Fundus photograph cropped around the optic nerve head; camera: Topcon TRC — 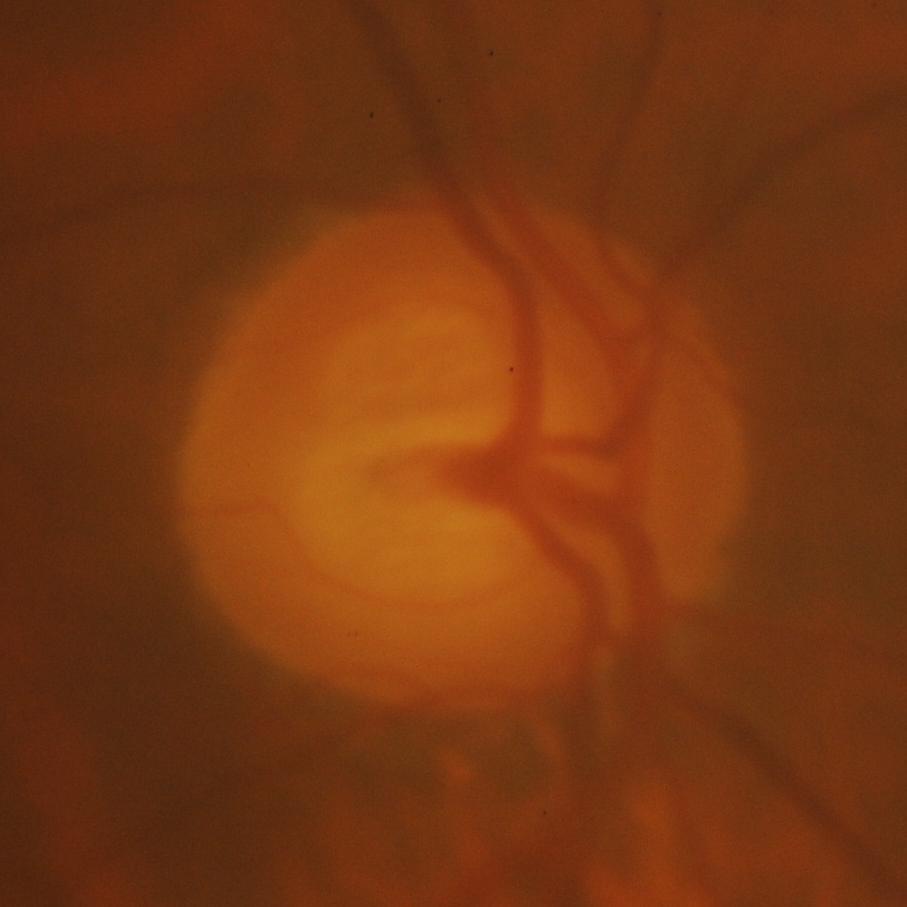

Glaucoma diagnosis = glaucomatous optic neuropathy.